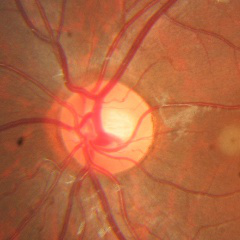
Q: Does this eye have glaucoma?
A: No — no evidence of glaucoma.